1240 by 1240 pixels. Phoenix ICON wide-field infant fundus image: 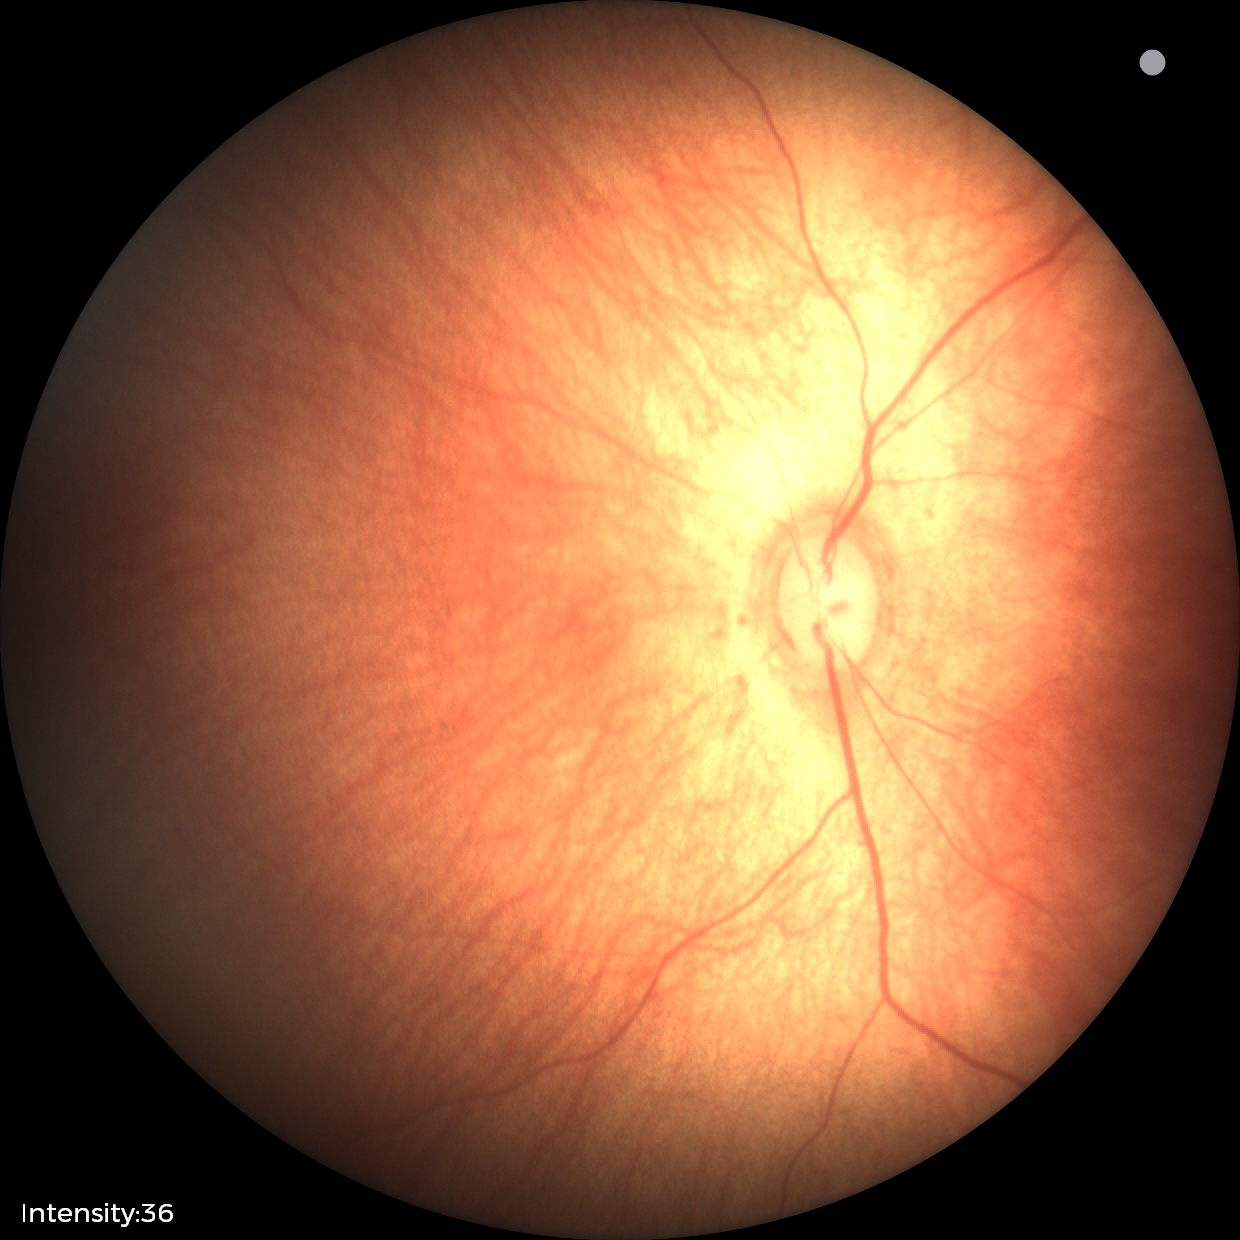 No retinal pathology identified on screening.